Pediatric wide-field fundus photograph; captured with the Phoenix ICON (100° field of view) — 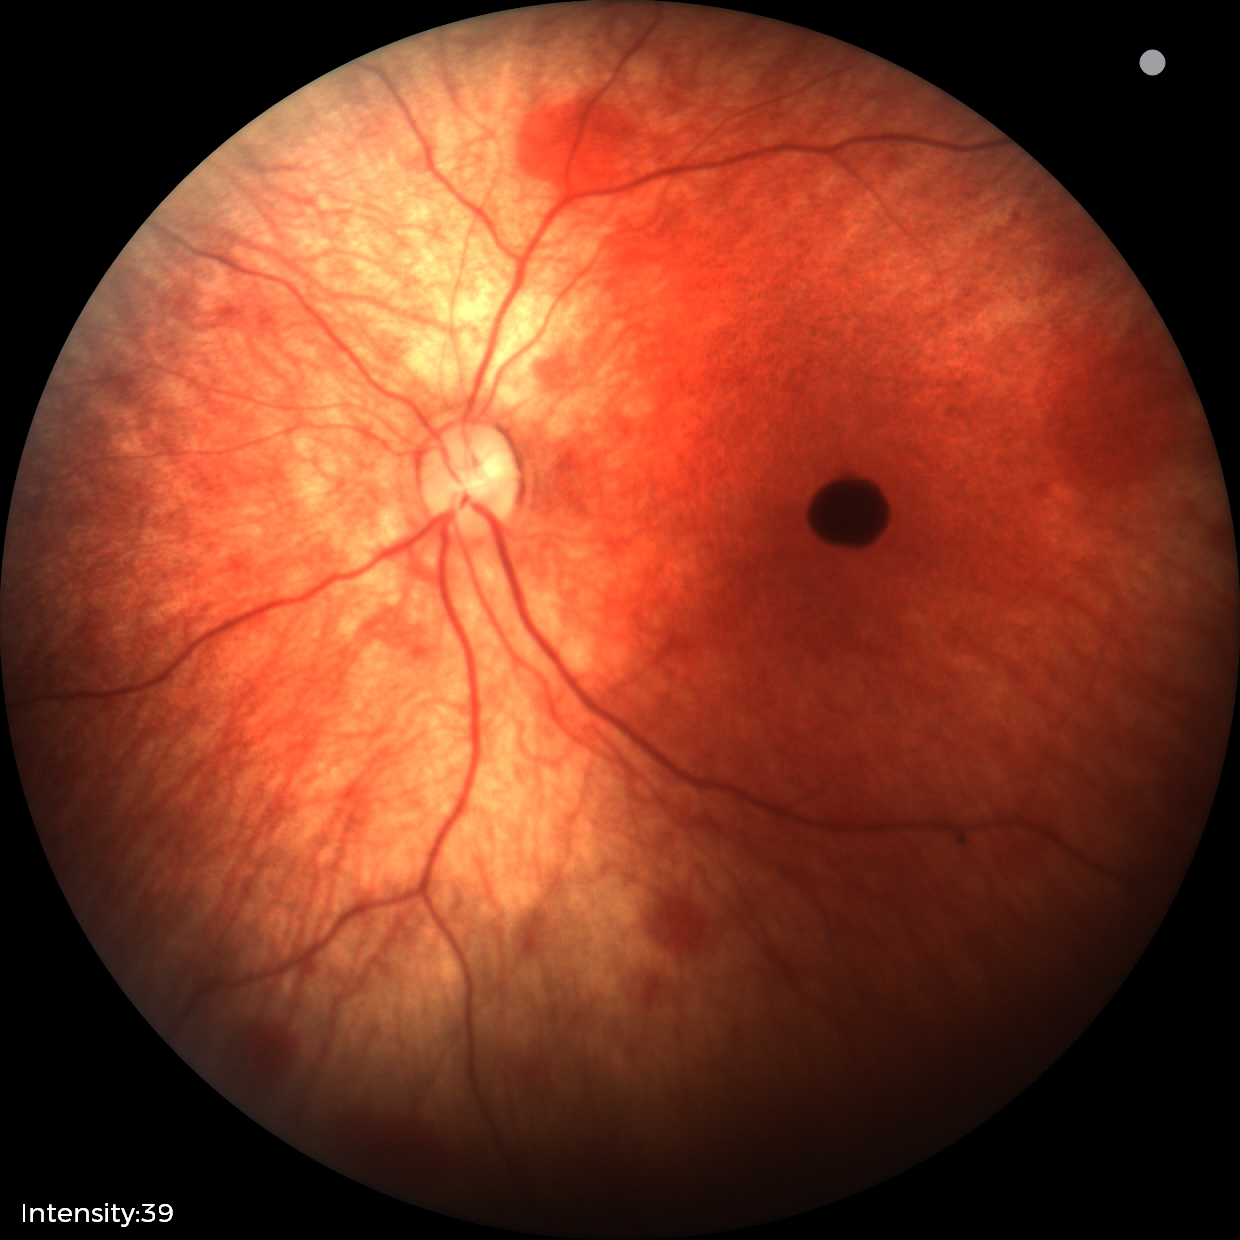
Screening examination consistent with retinal hemorrhages.